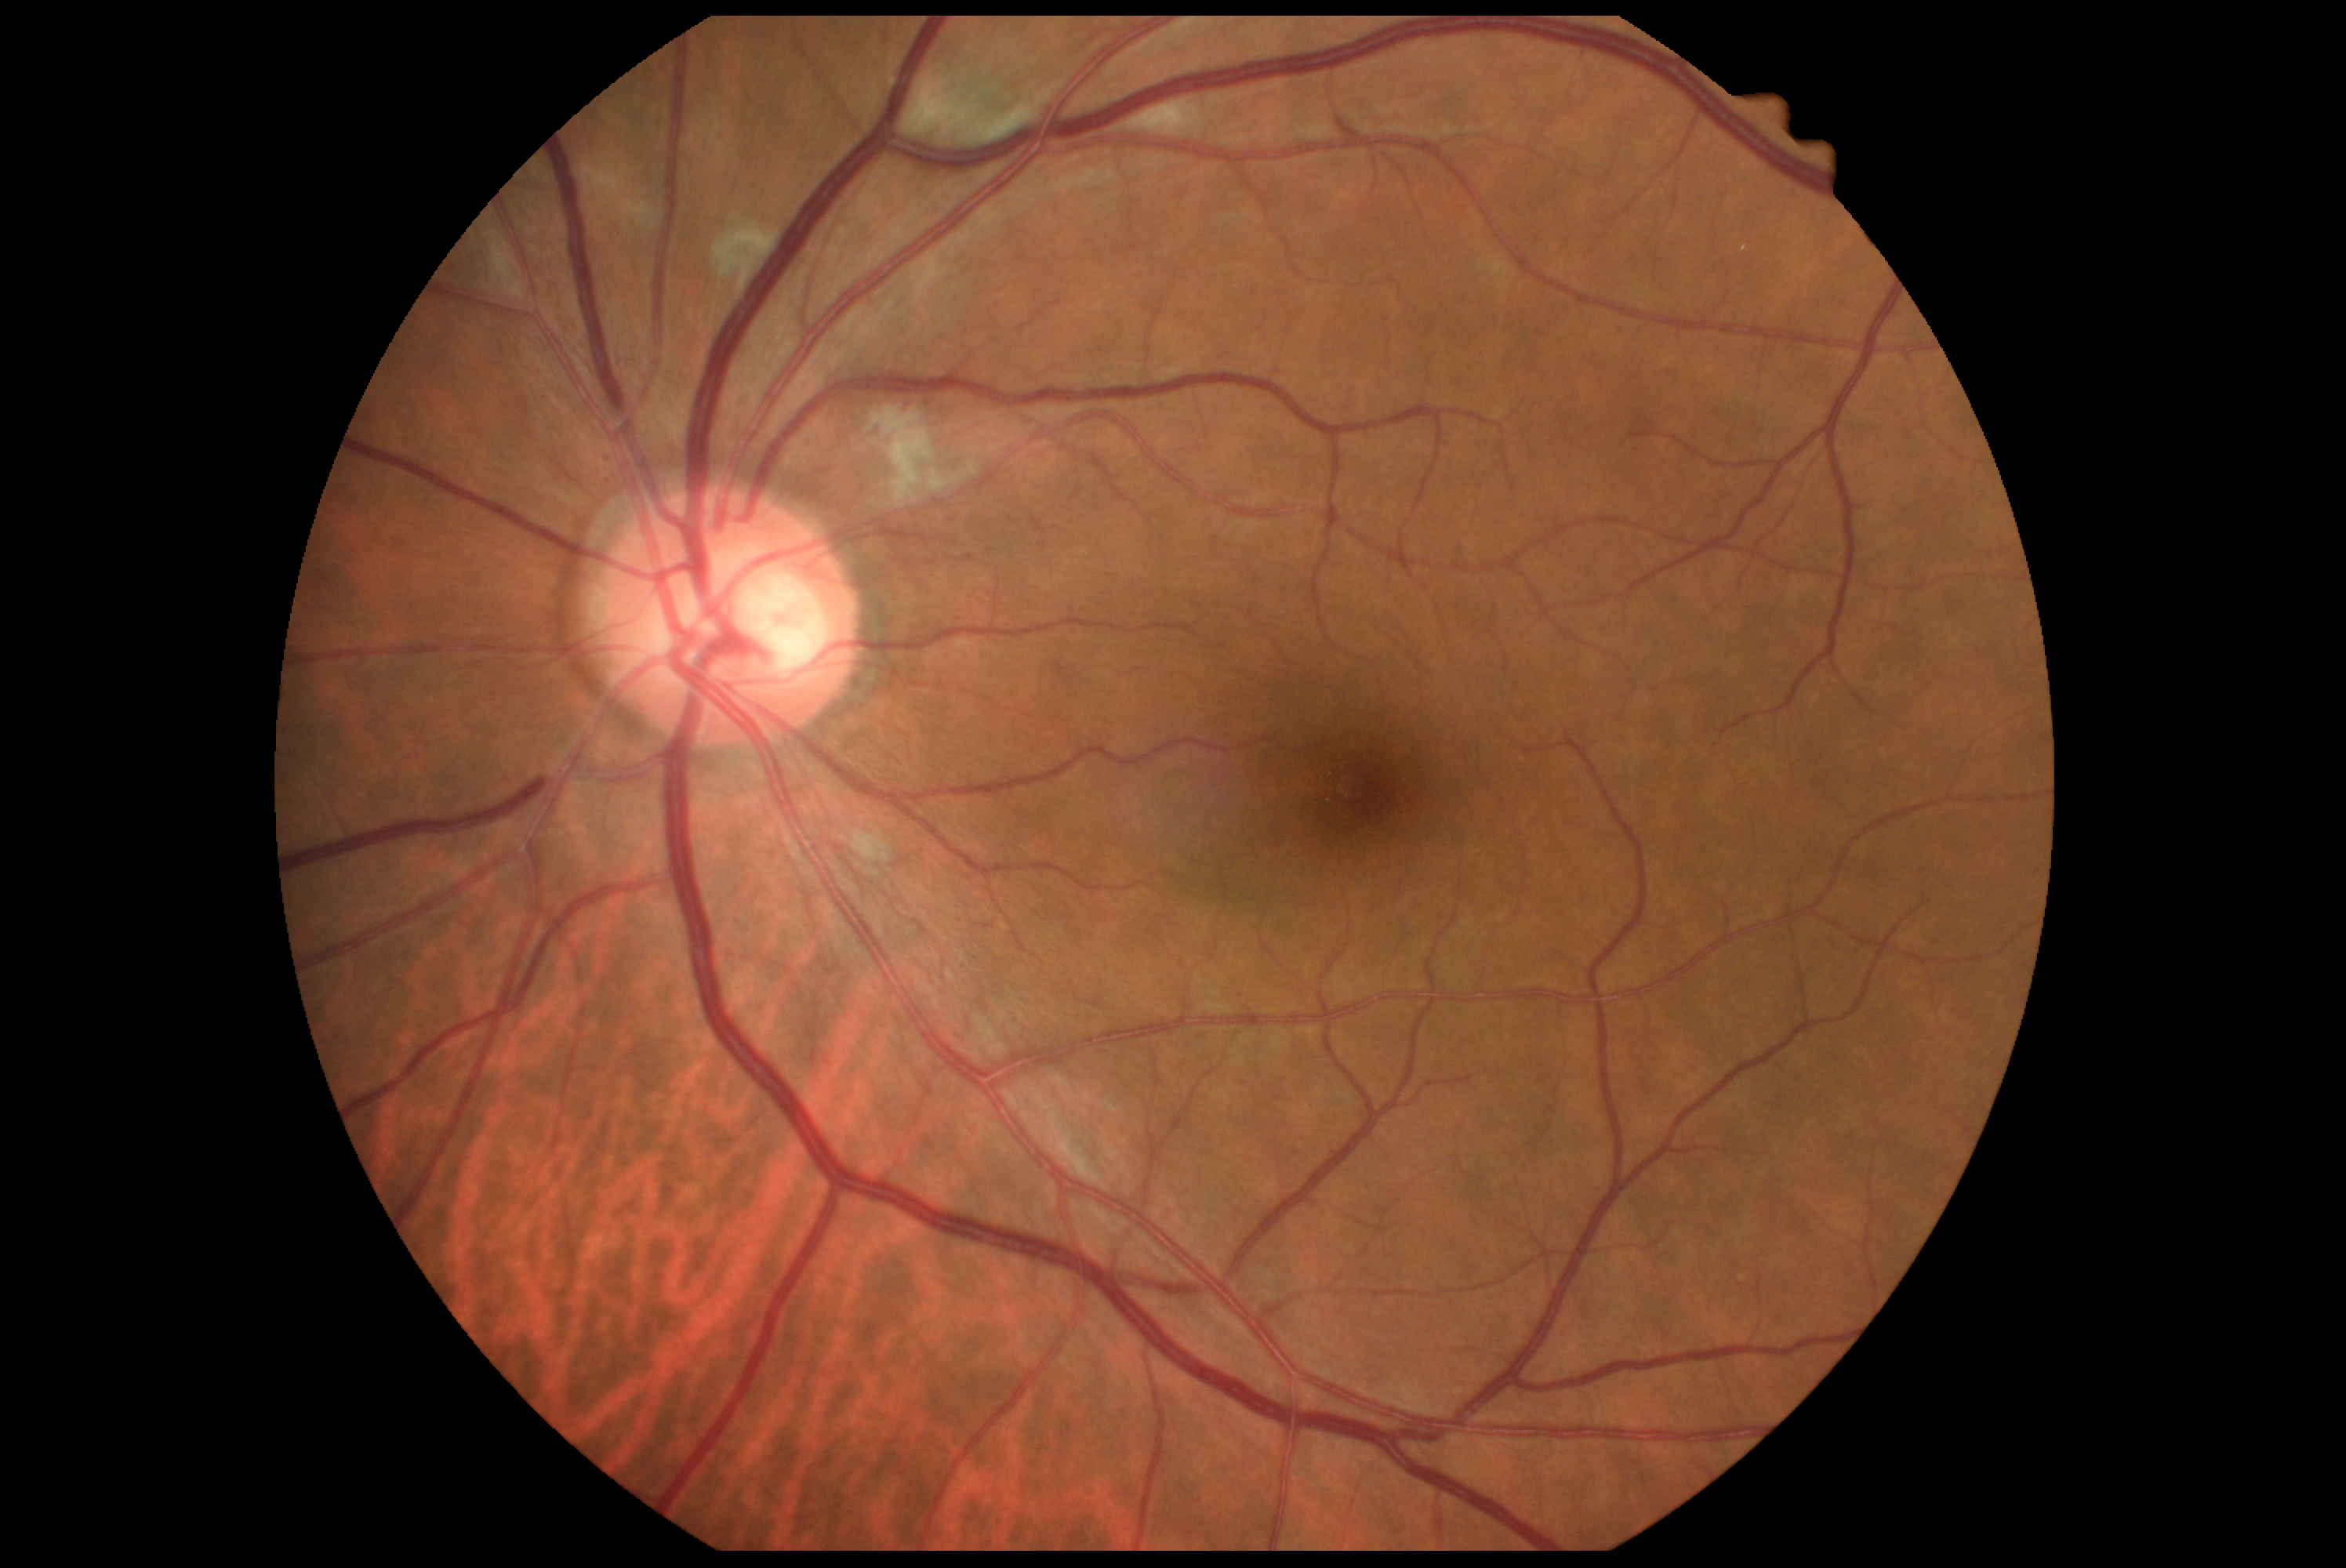 Diabetic retinopathy (DR) is moderate non-proliferative diabetic retinopathy (grade 2).